45° field of view:
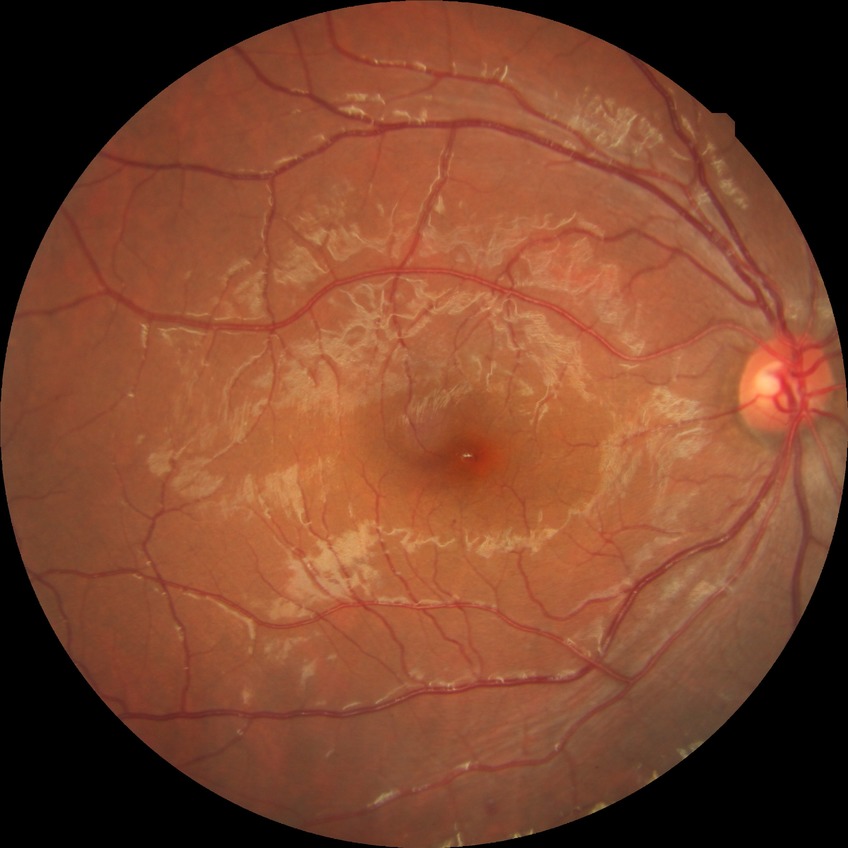 Diabetic retinopathy (DR): SDR (simple diabetic retinopathy). Disease class: non-proliferative diabetic retinopathy.